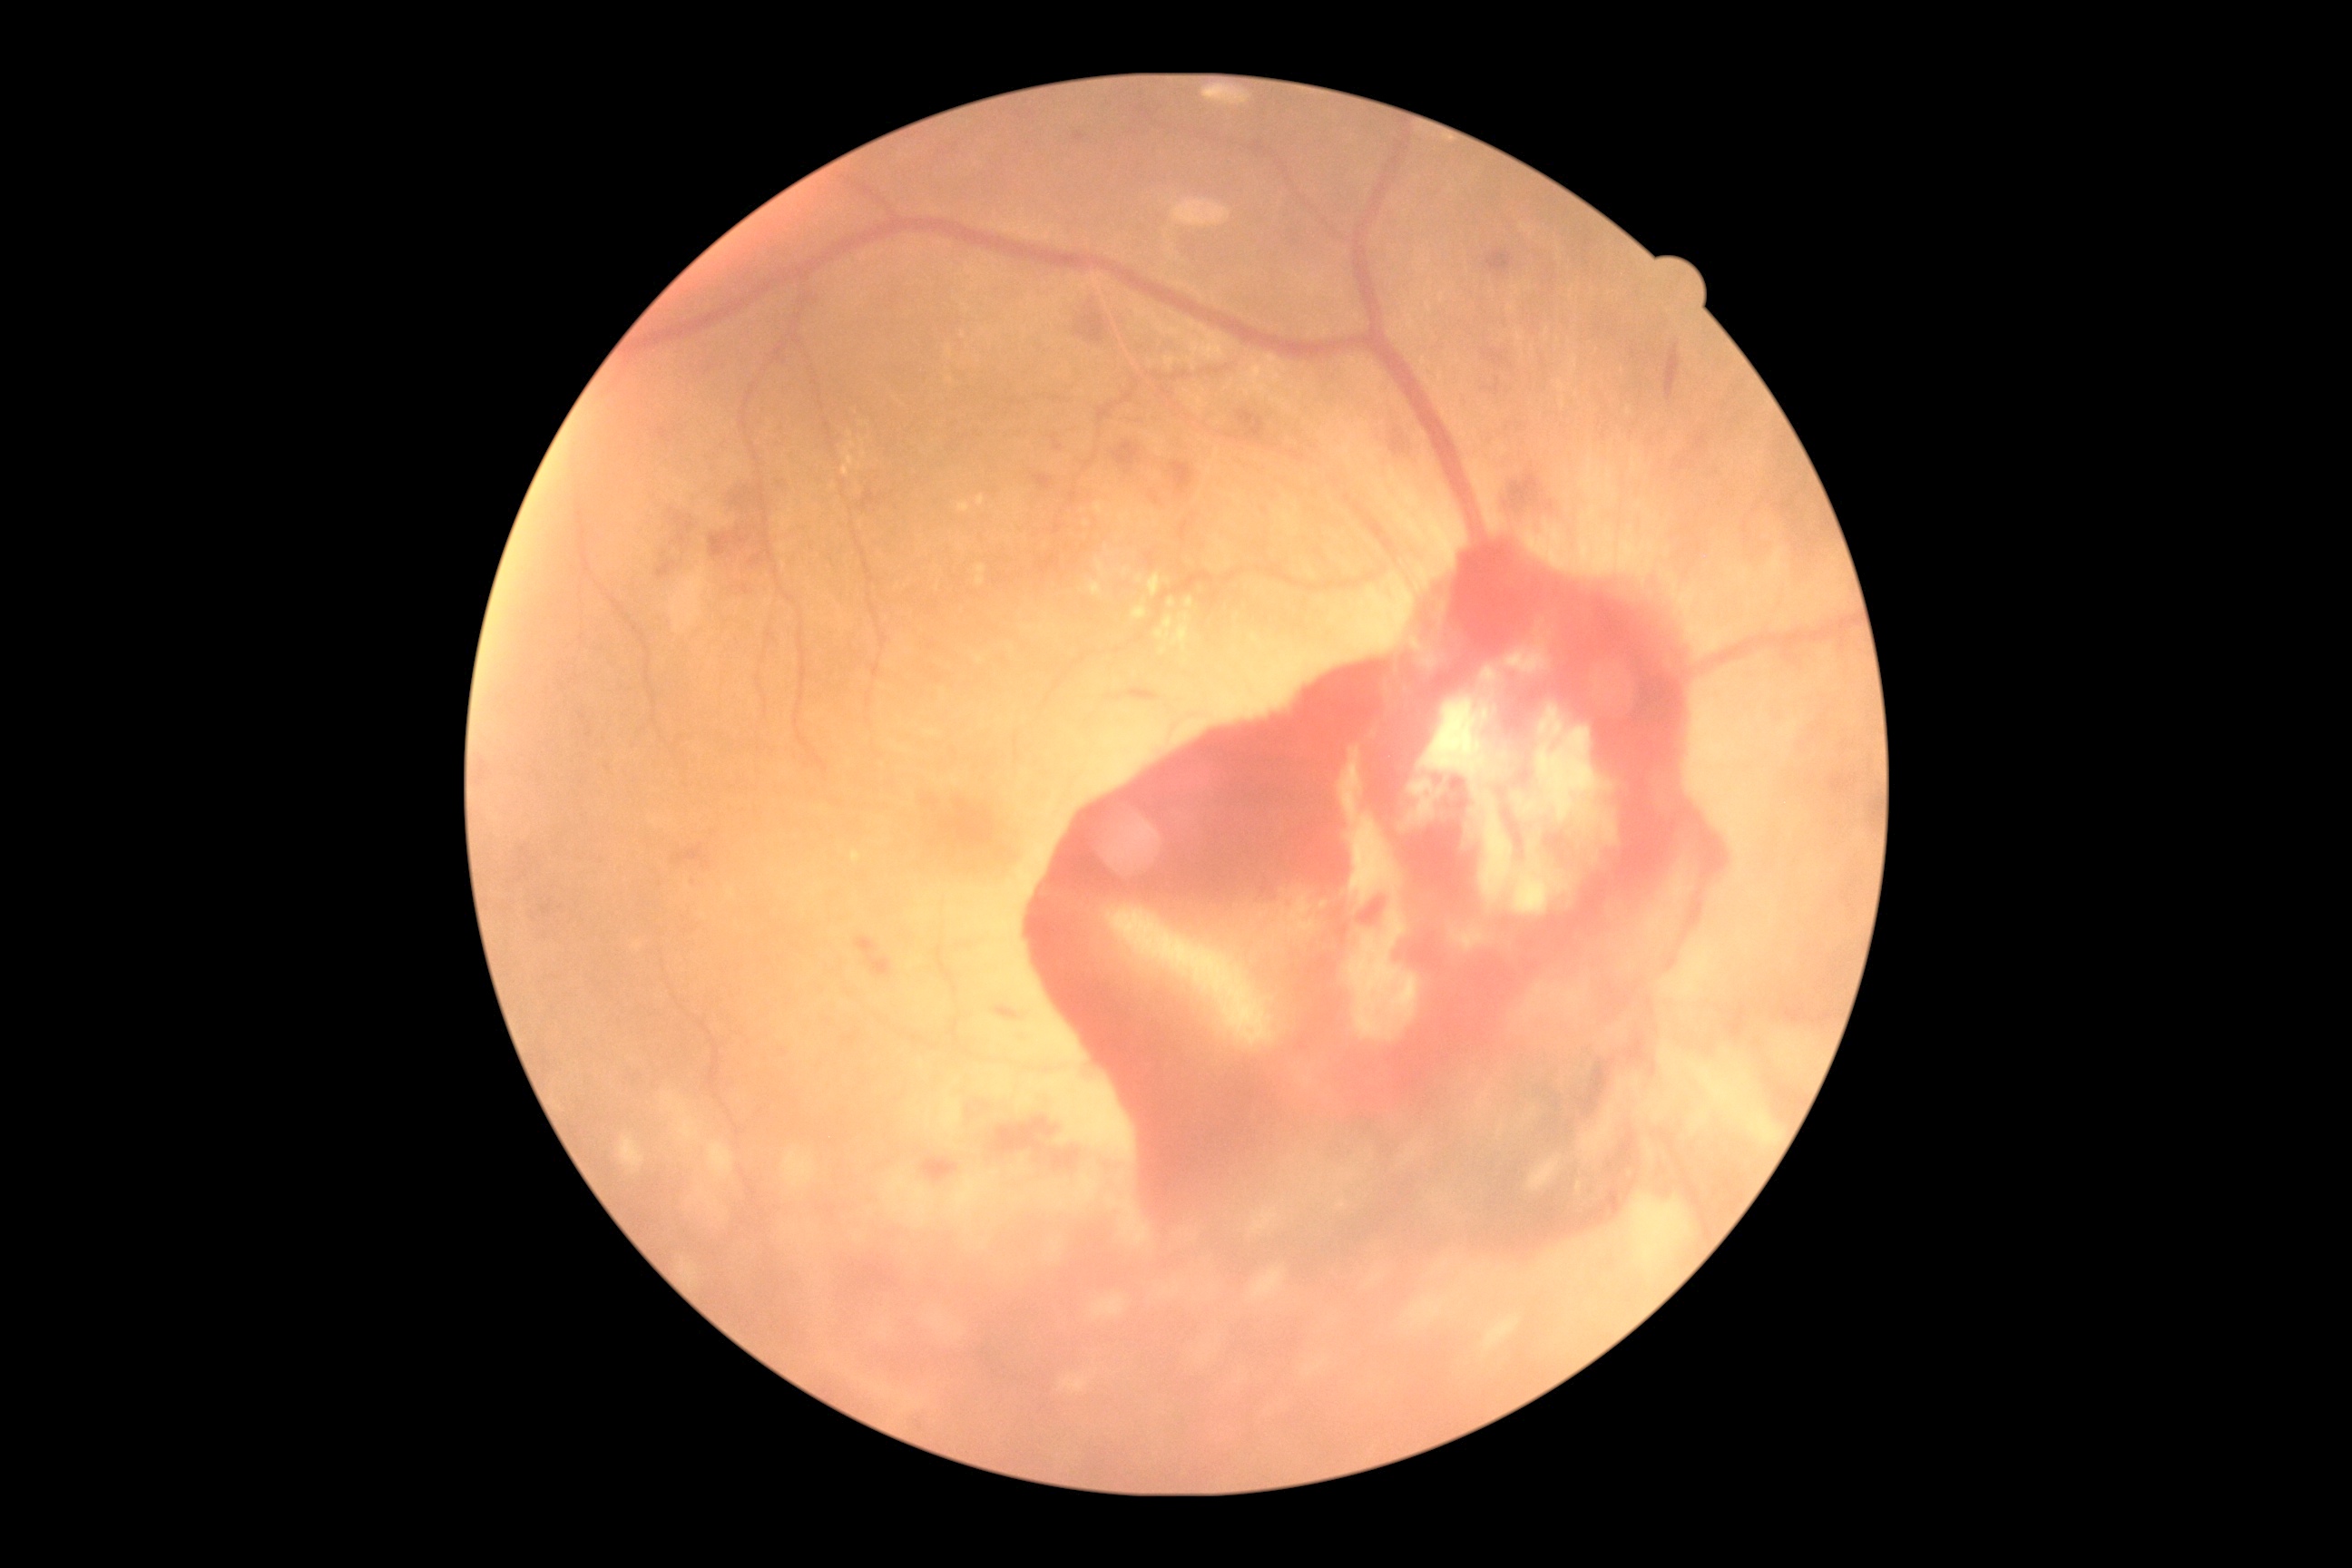

Diabetic retinopathy (DR) is grade 4 (PDR) — neovascularization and/or vitreous/pre-retinal hemorrhage.